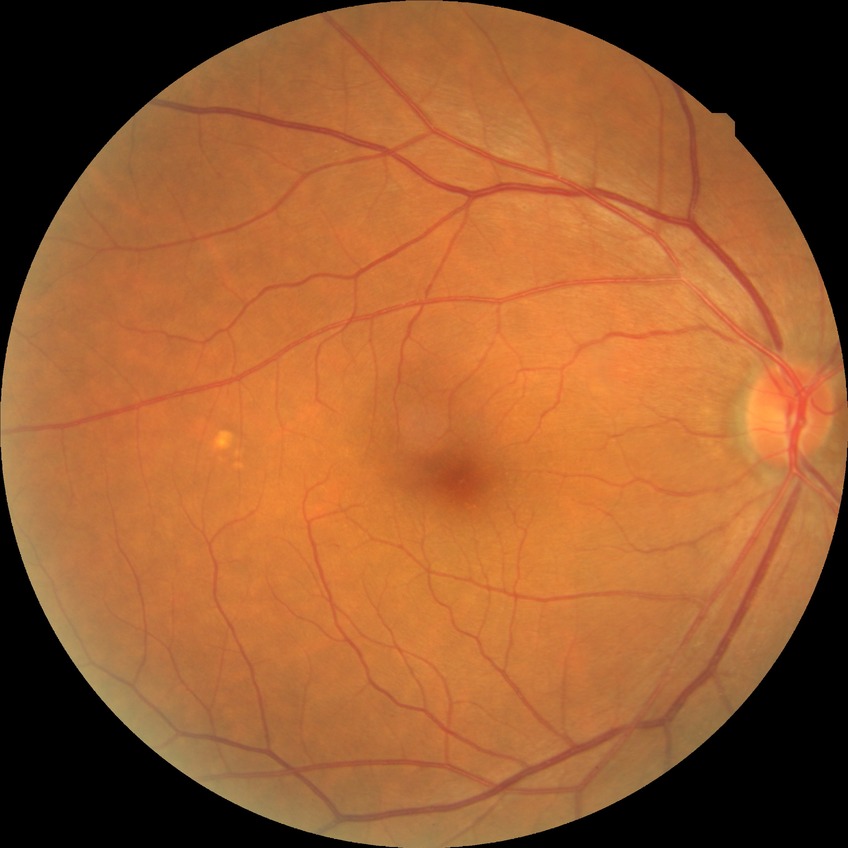

- diabetic retinopathy (DR) — NDR (no diabetic retinopathy)